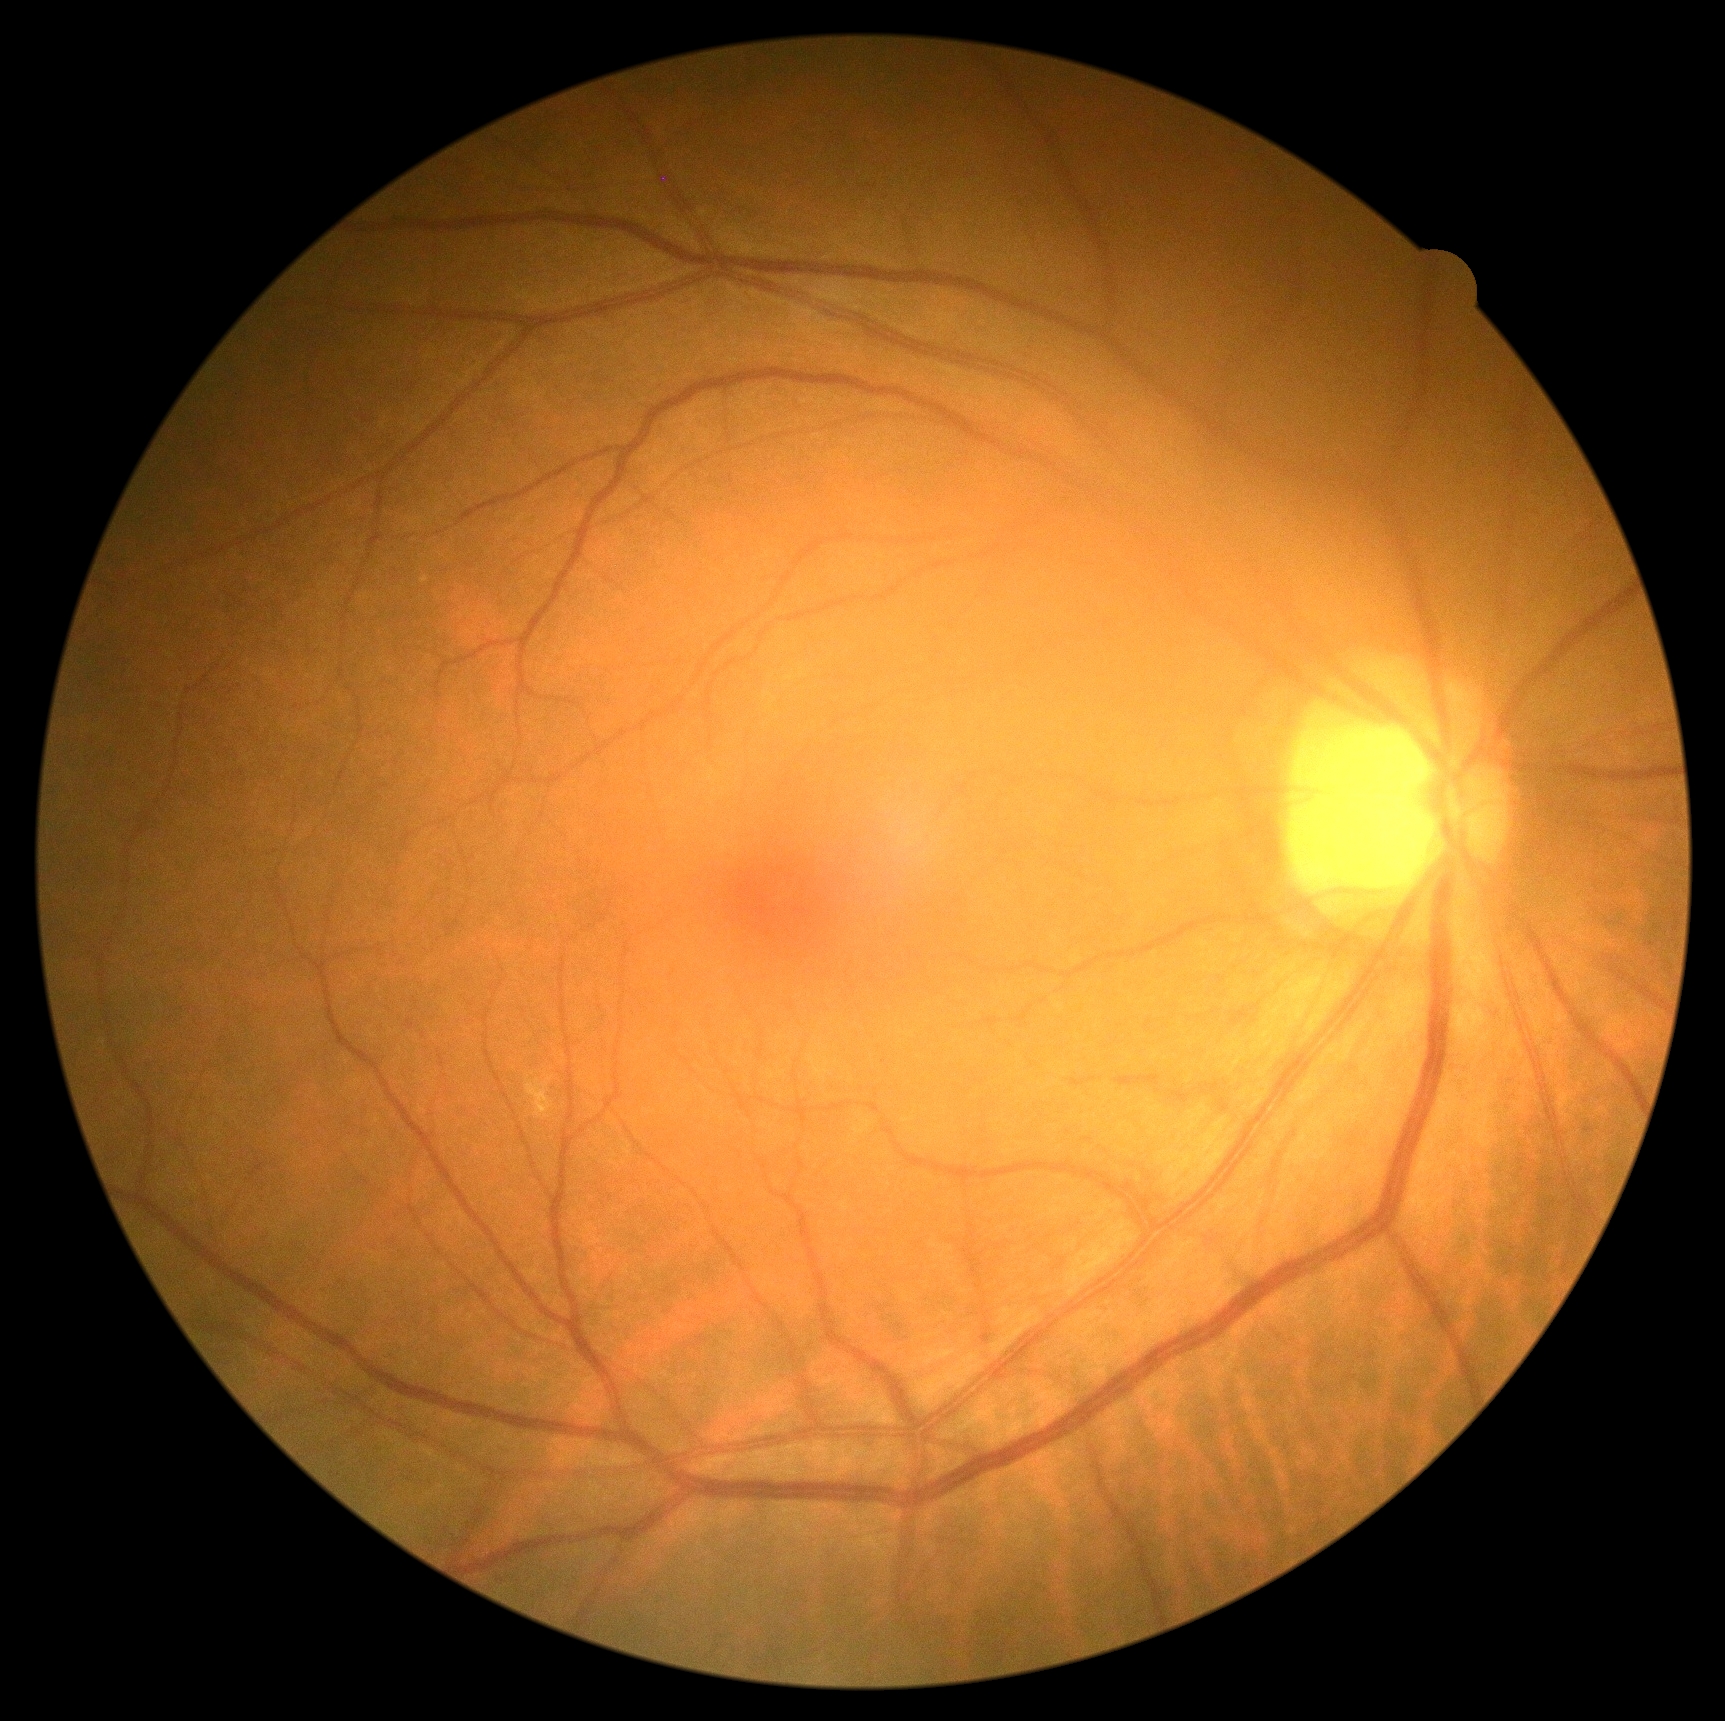

Annotations:
- diabetic retinopathy severity — grade 2